Posterior pole color fundus photograph · NIDEK AFC-230 fundus camera:
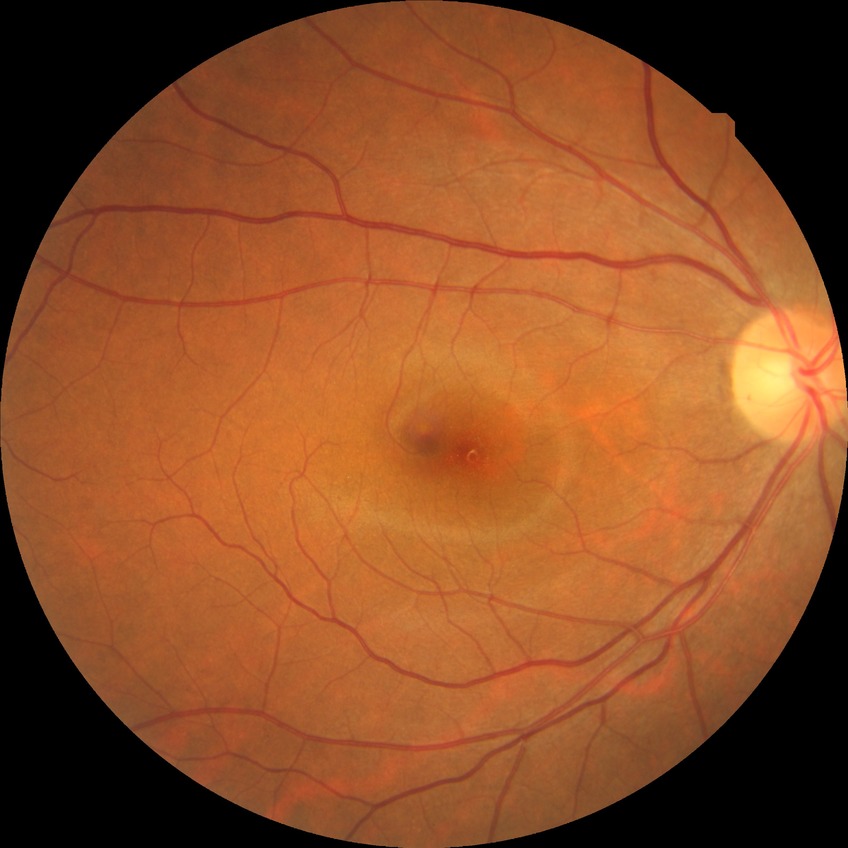
Retinopathy grade is no diabetic retinopathy.